CFP — 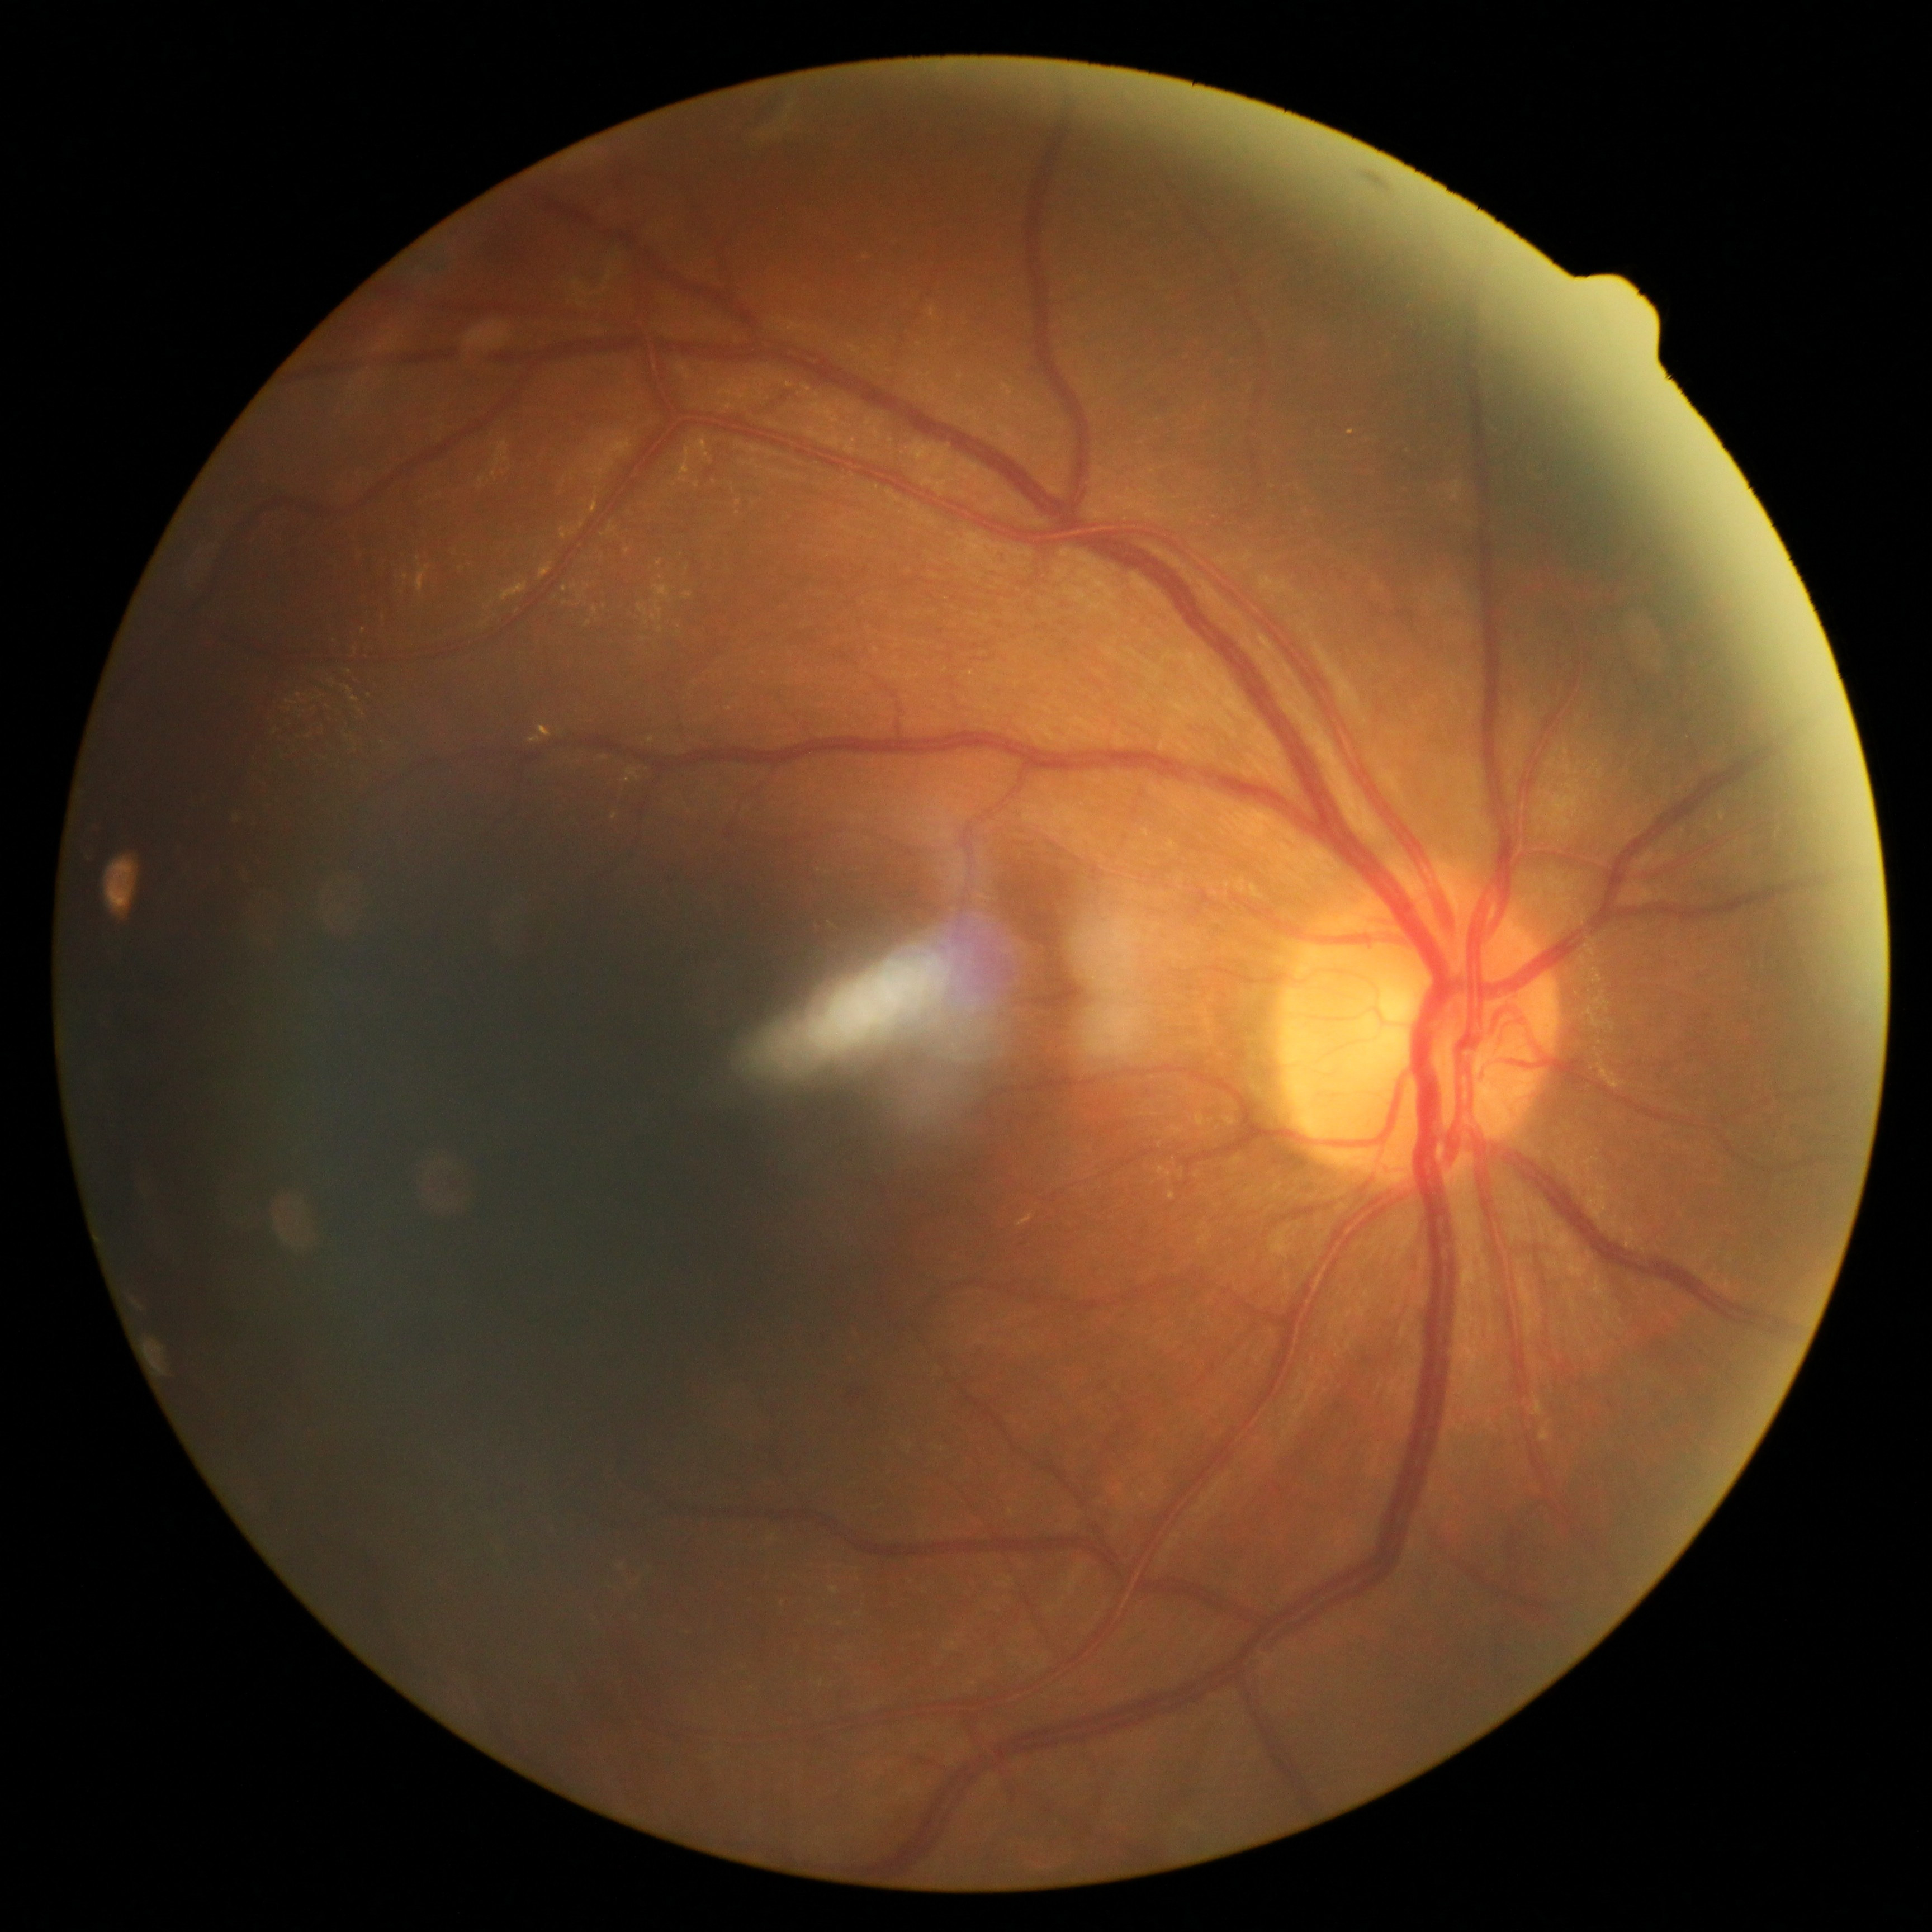

DR: 1.